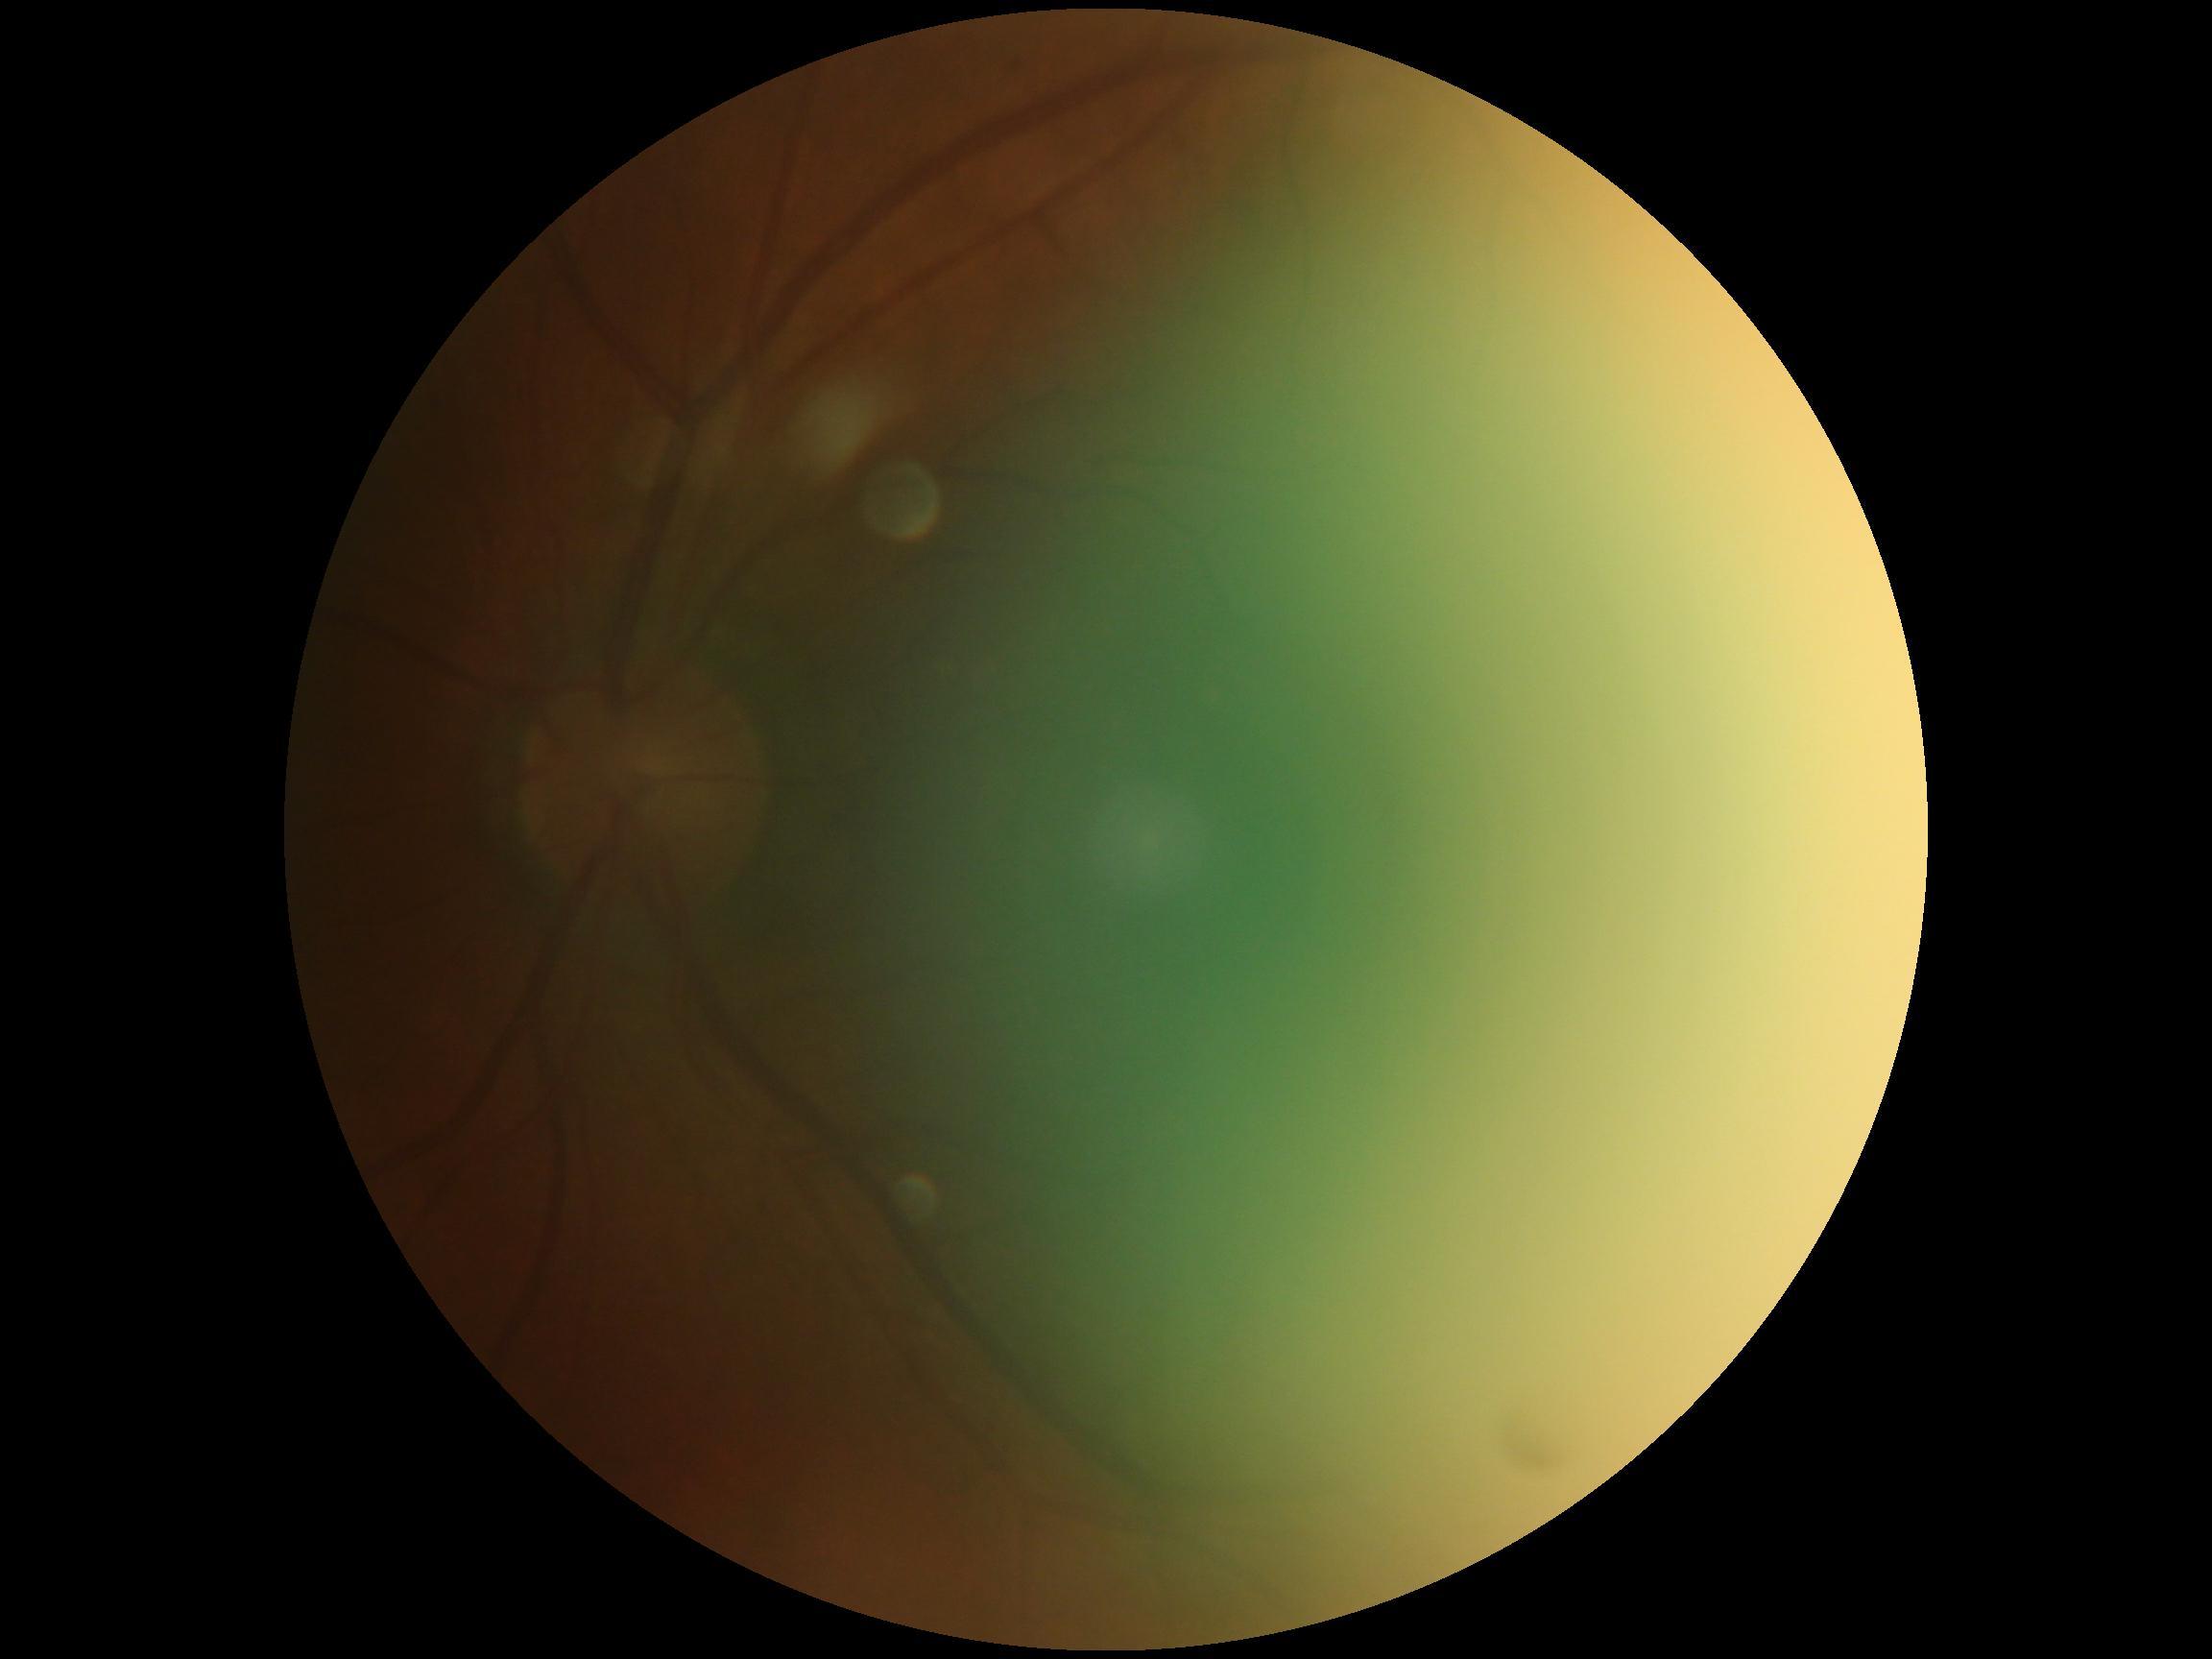
diabetic retinopathy (DR): ungradable due to poor image quality.